Color fundus photograph.
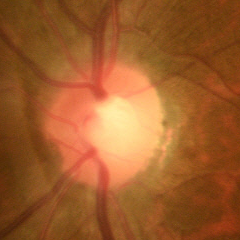
Glaucoma diagnosis: no evidence of glaucoma.